NIDEK AFC-230.
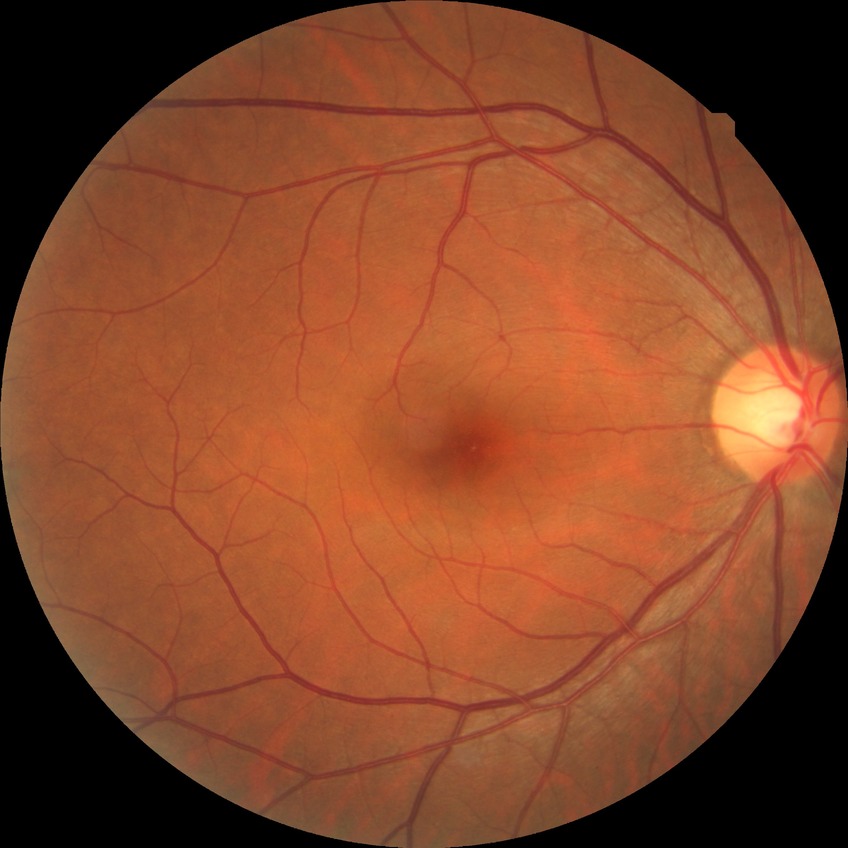 davis_grade: NDR